Image size 240x240, non-mydriatic.
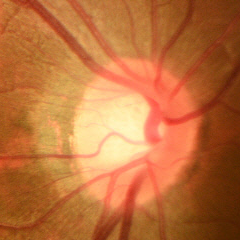
Glaucoma assessment = no glaucomatous optic neuropathy.